240 x 240 pixels. Centered on the optic disc — 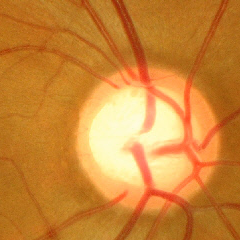
Diagnosis: advanced glaucomatous optic neuropathy.